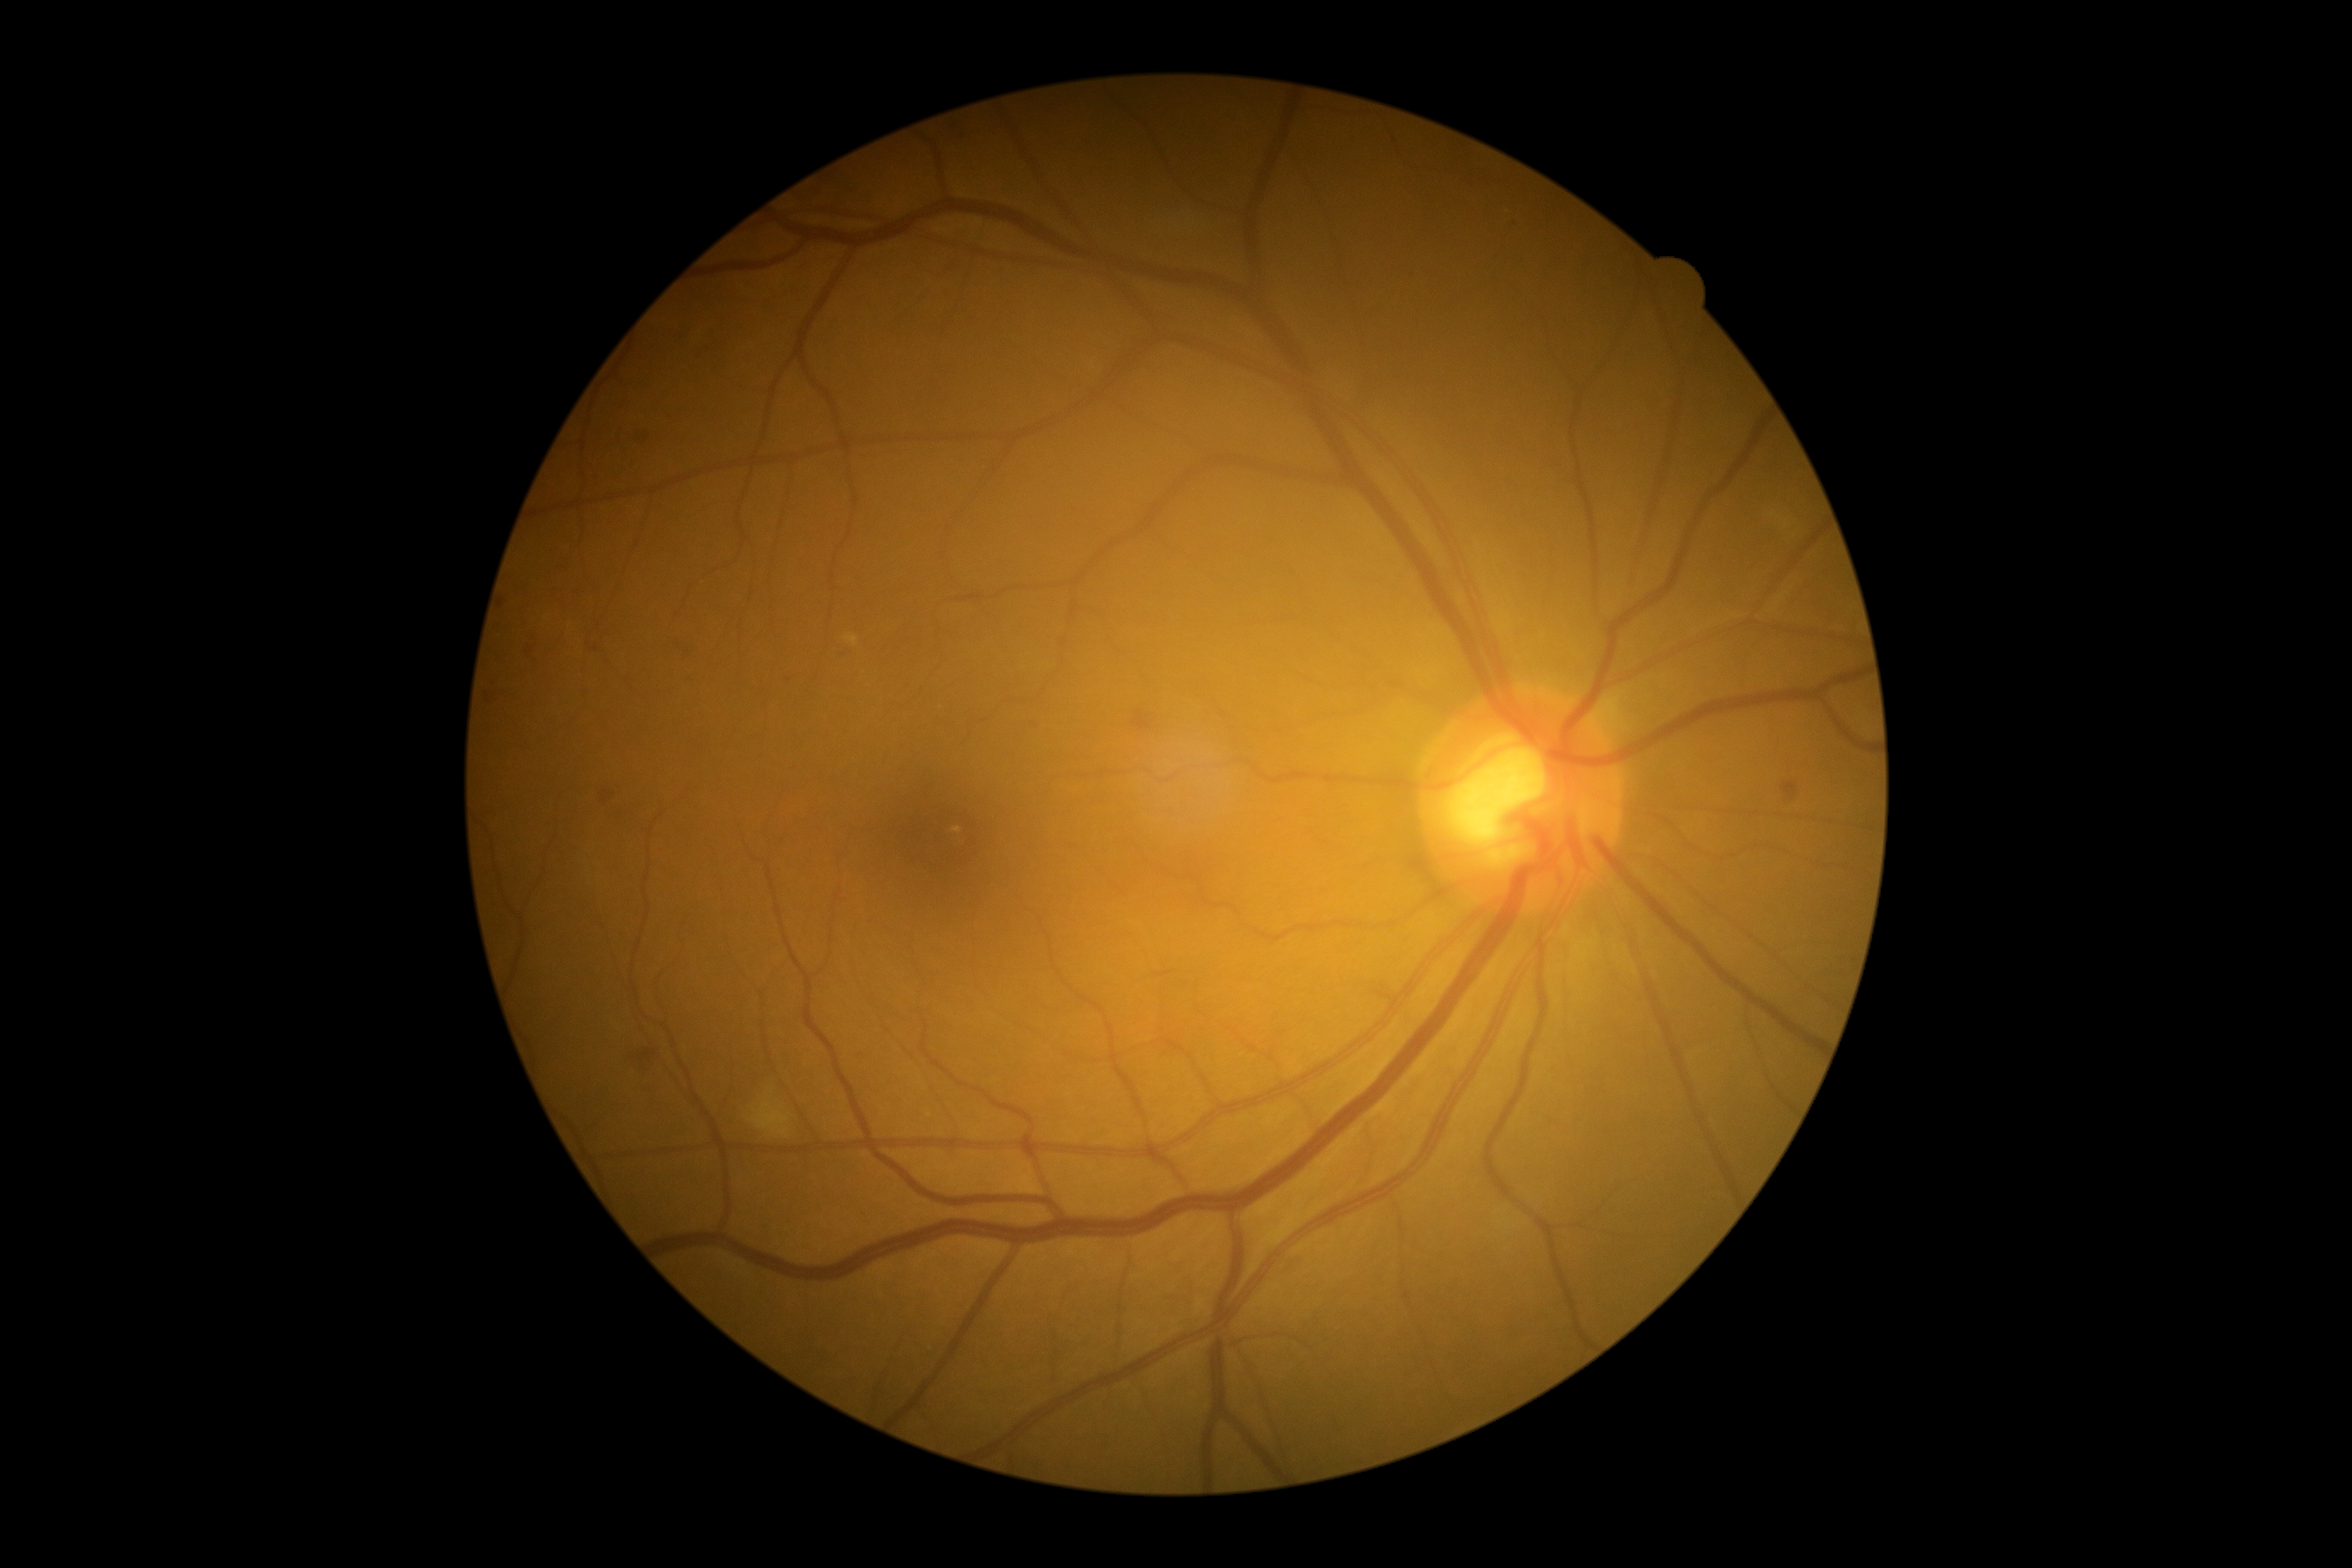
DR severity is moderate non-proliferative diabetic retinopathy (grade 2).